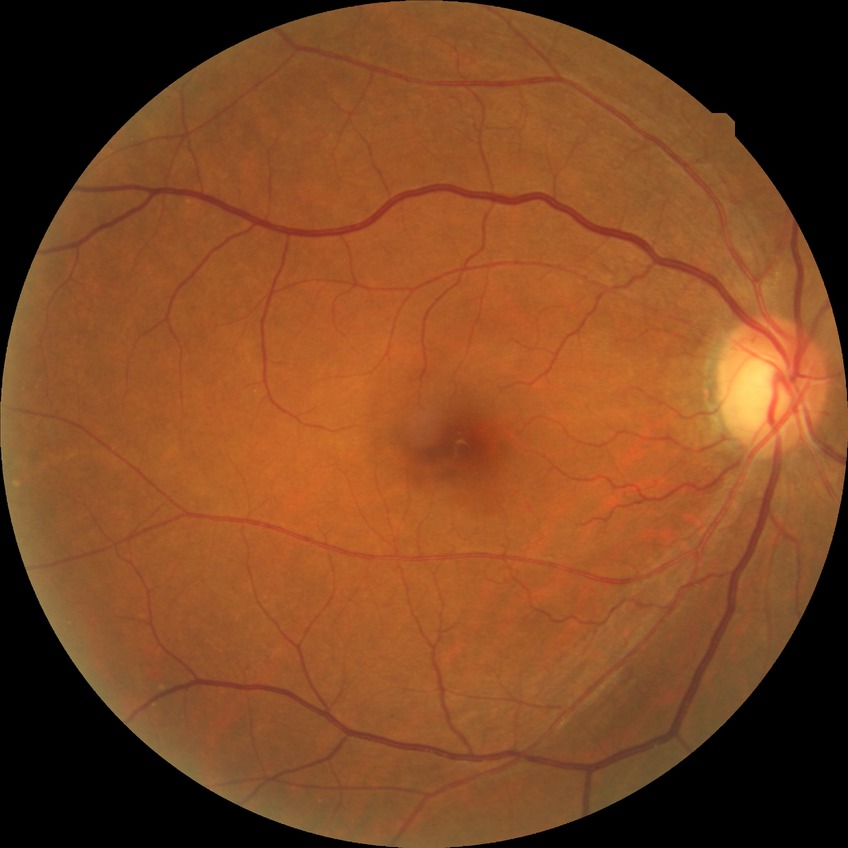 Annotations:
• diabetic retinopathy (DR) — NDR (no diabetic retinopathy)